640x480. Wide-field fundus photograph of an infant. Captured with the Clarity RetCam 3 (130° field of view).
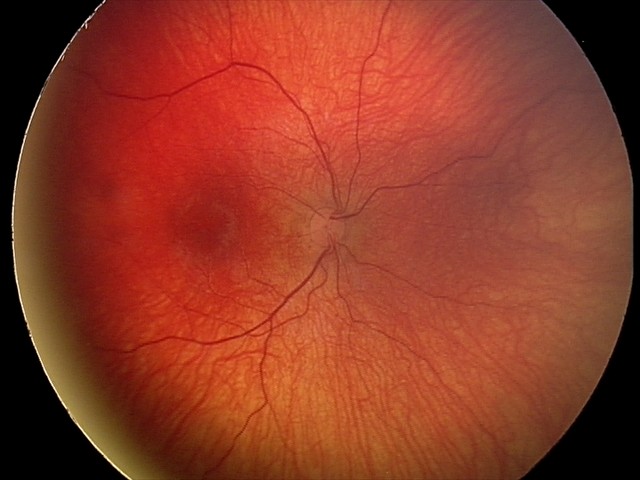 Diagnosis from this screening exam: status post retinopathy of prematurity (ROP).